NIDEK AFC-230 fundus camera, 848x848px, graded on the modified Davis scale, nonmydriatic — 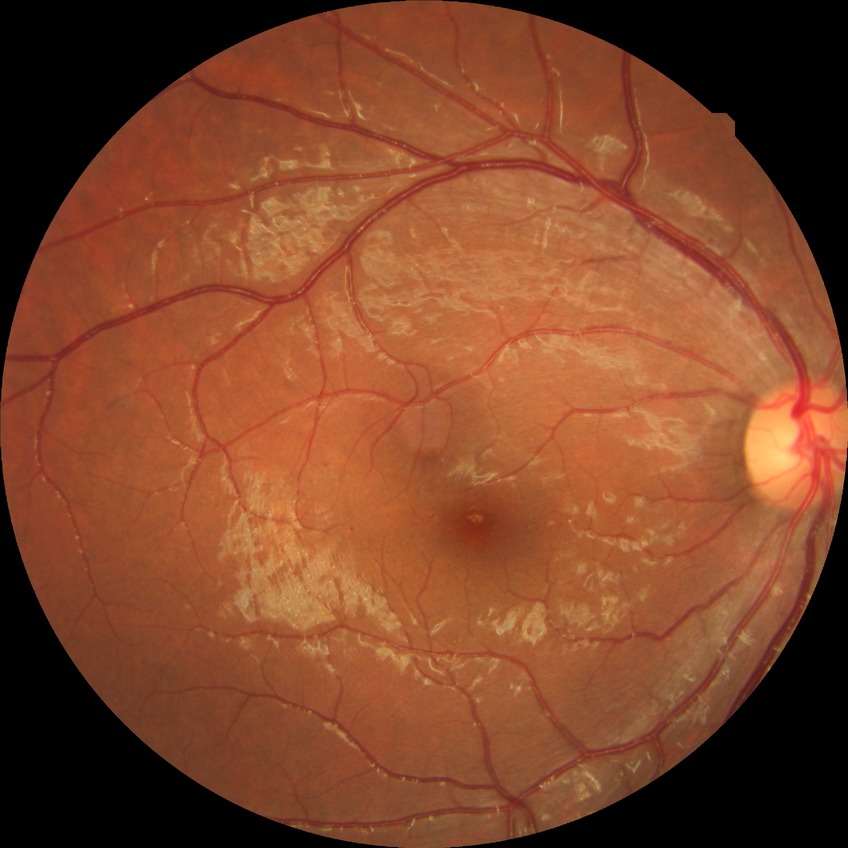
Assessment:
* diabetic retinopathy stage: simple diabetic retinopathy
* DR class: non-proliferative diabetic retinopathy